Captured with the Clarity RetCam 3 (130° field of view); infant wide-field retinal image
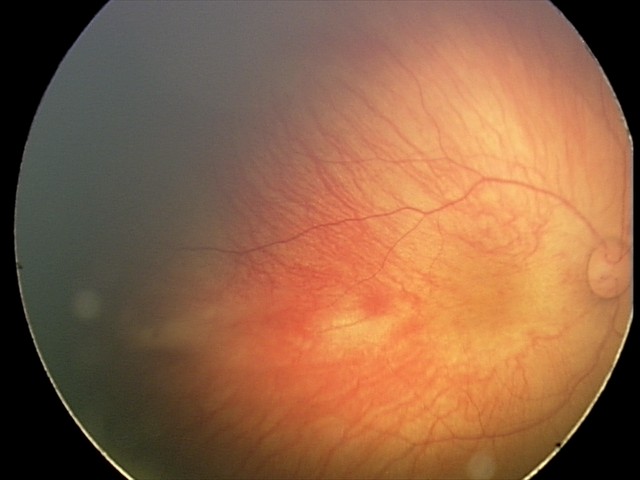

Screening series with retinal hemorrhages.